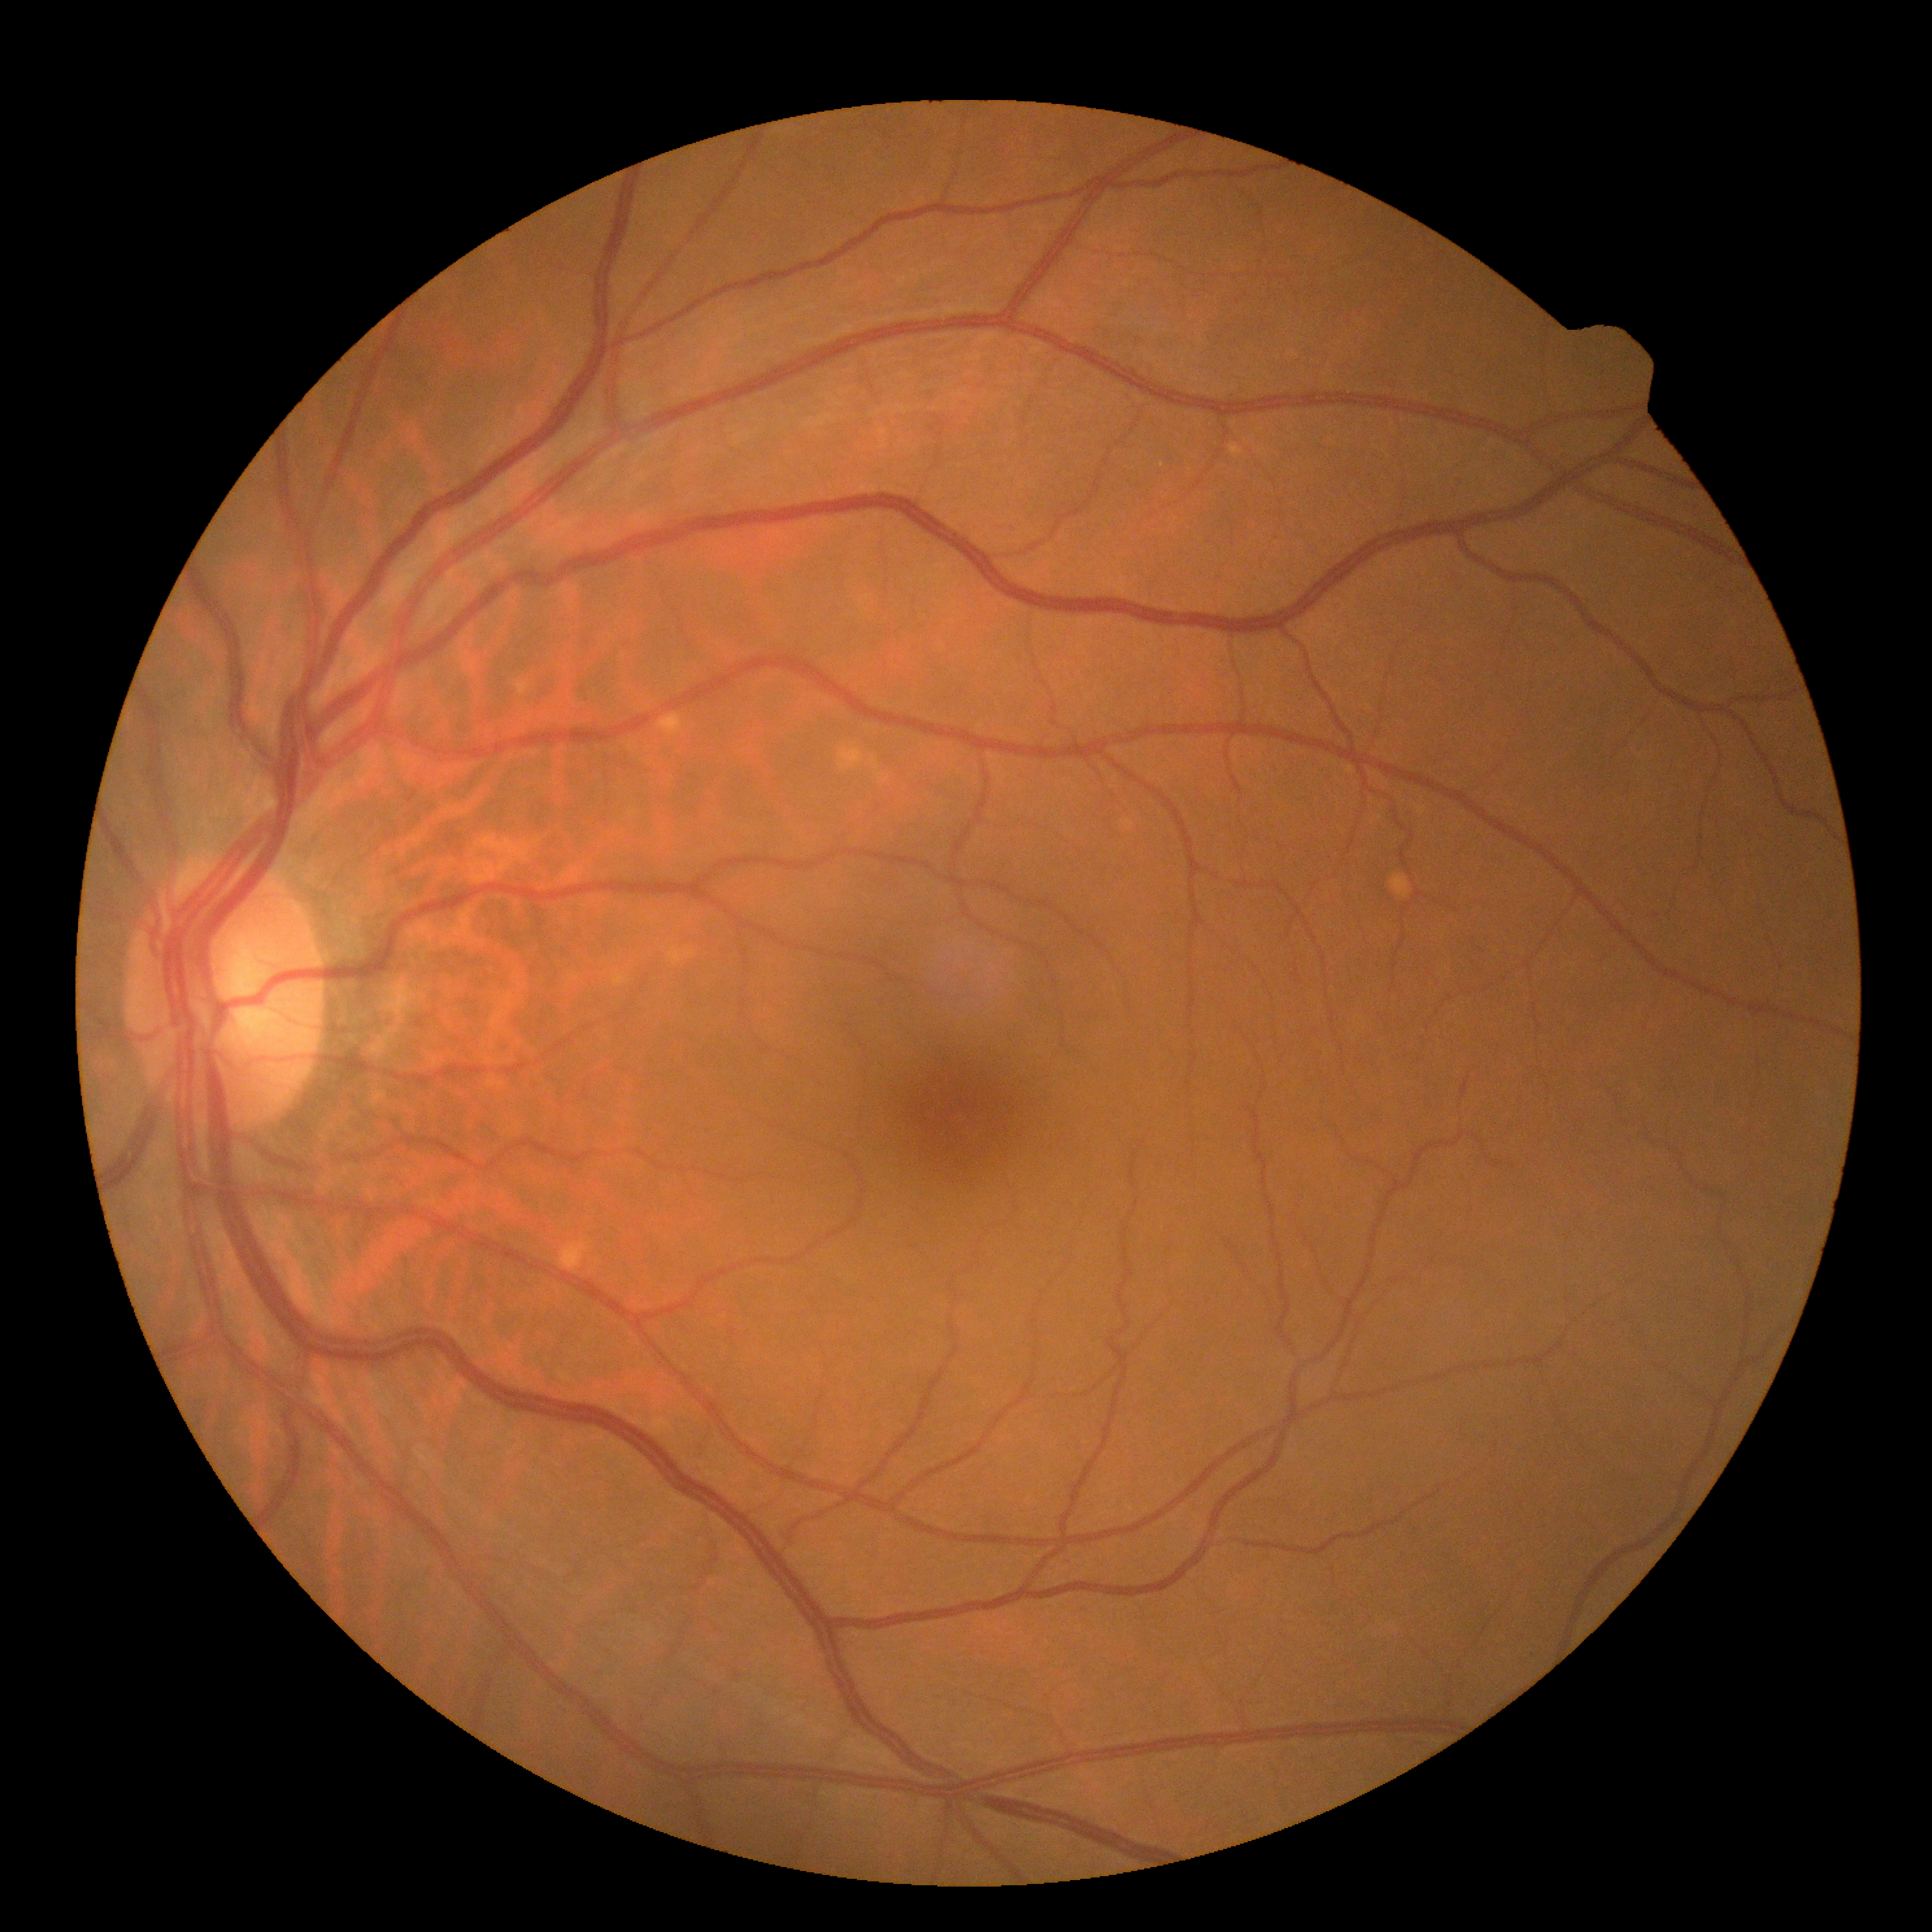
{
  "dr_grade": "0/4"
}